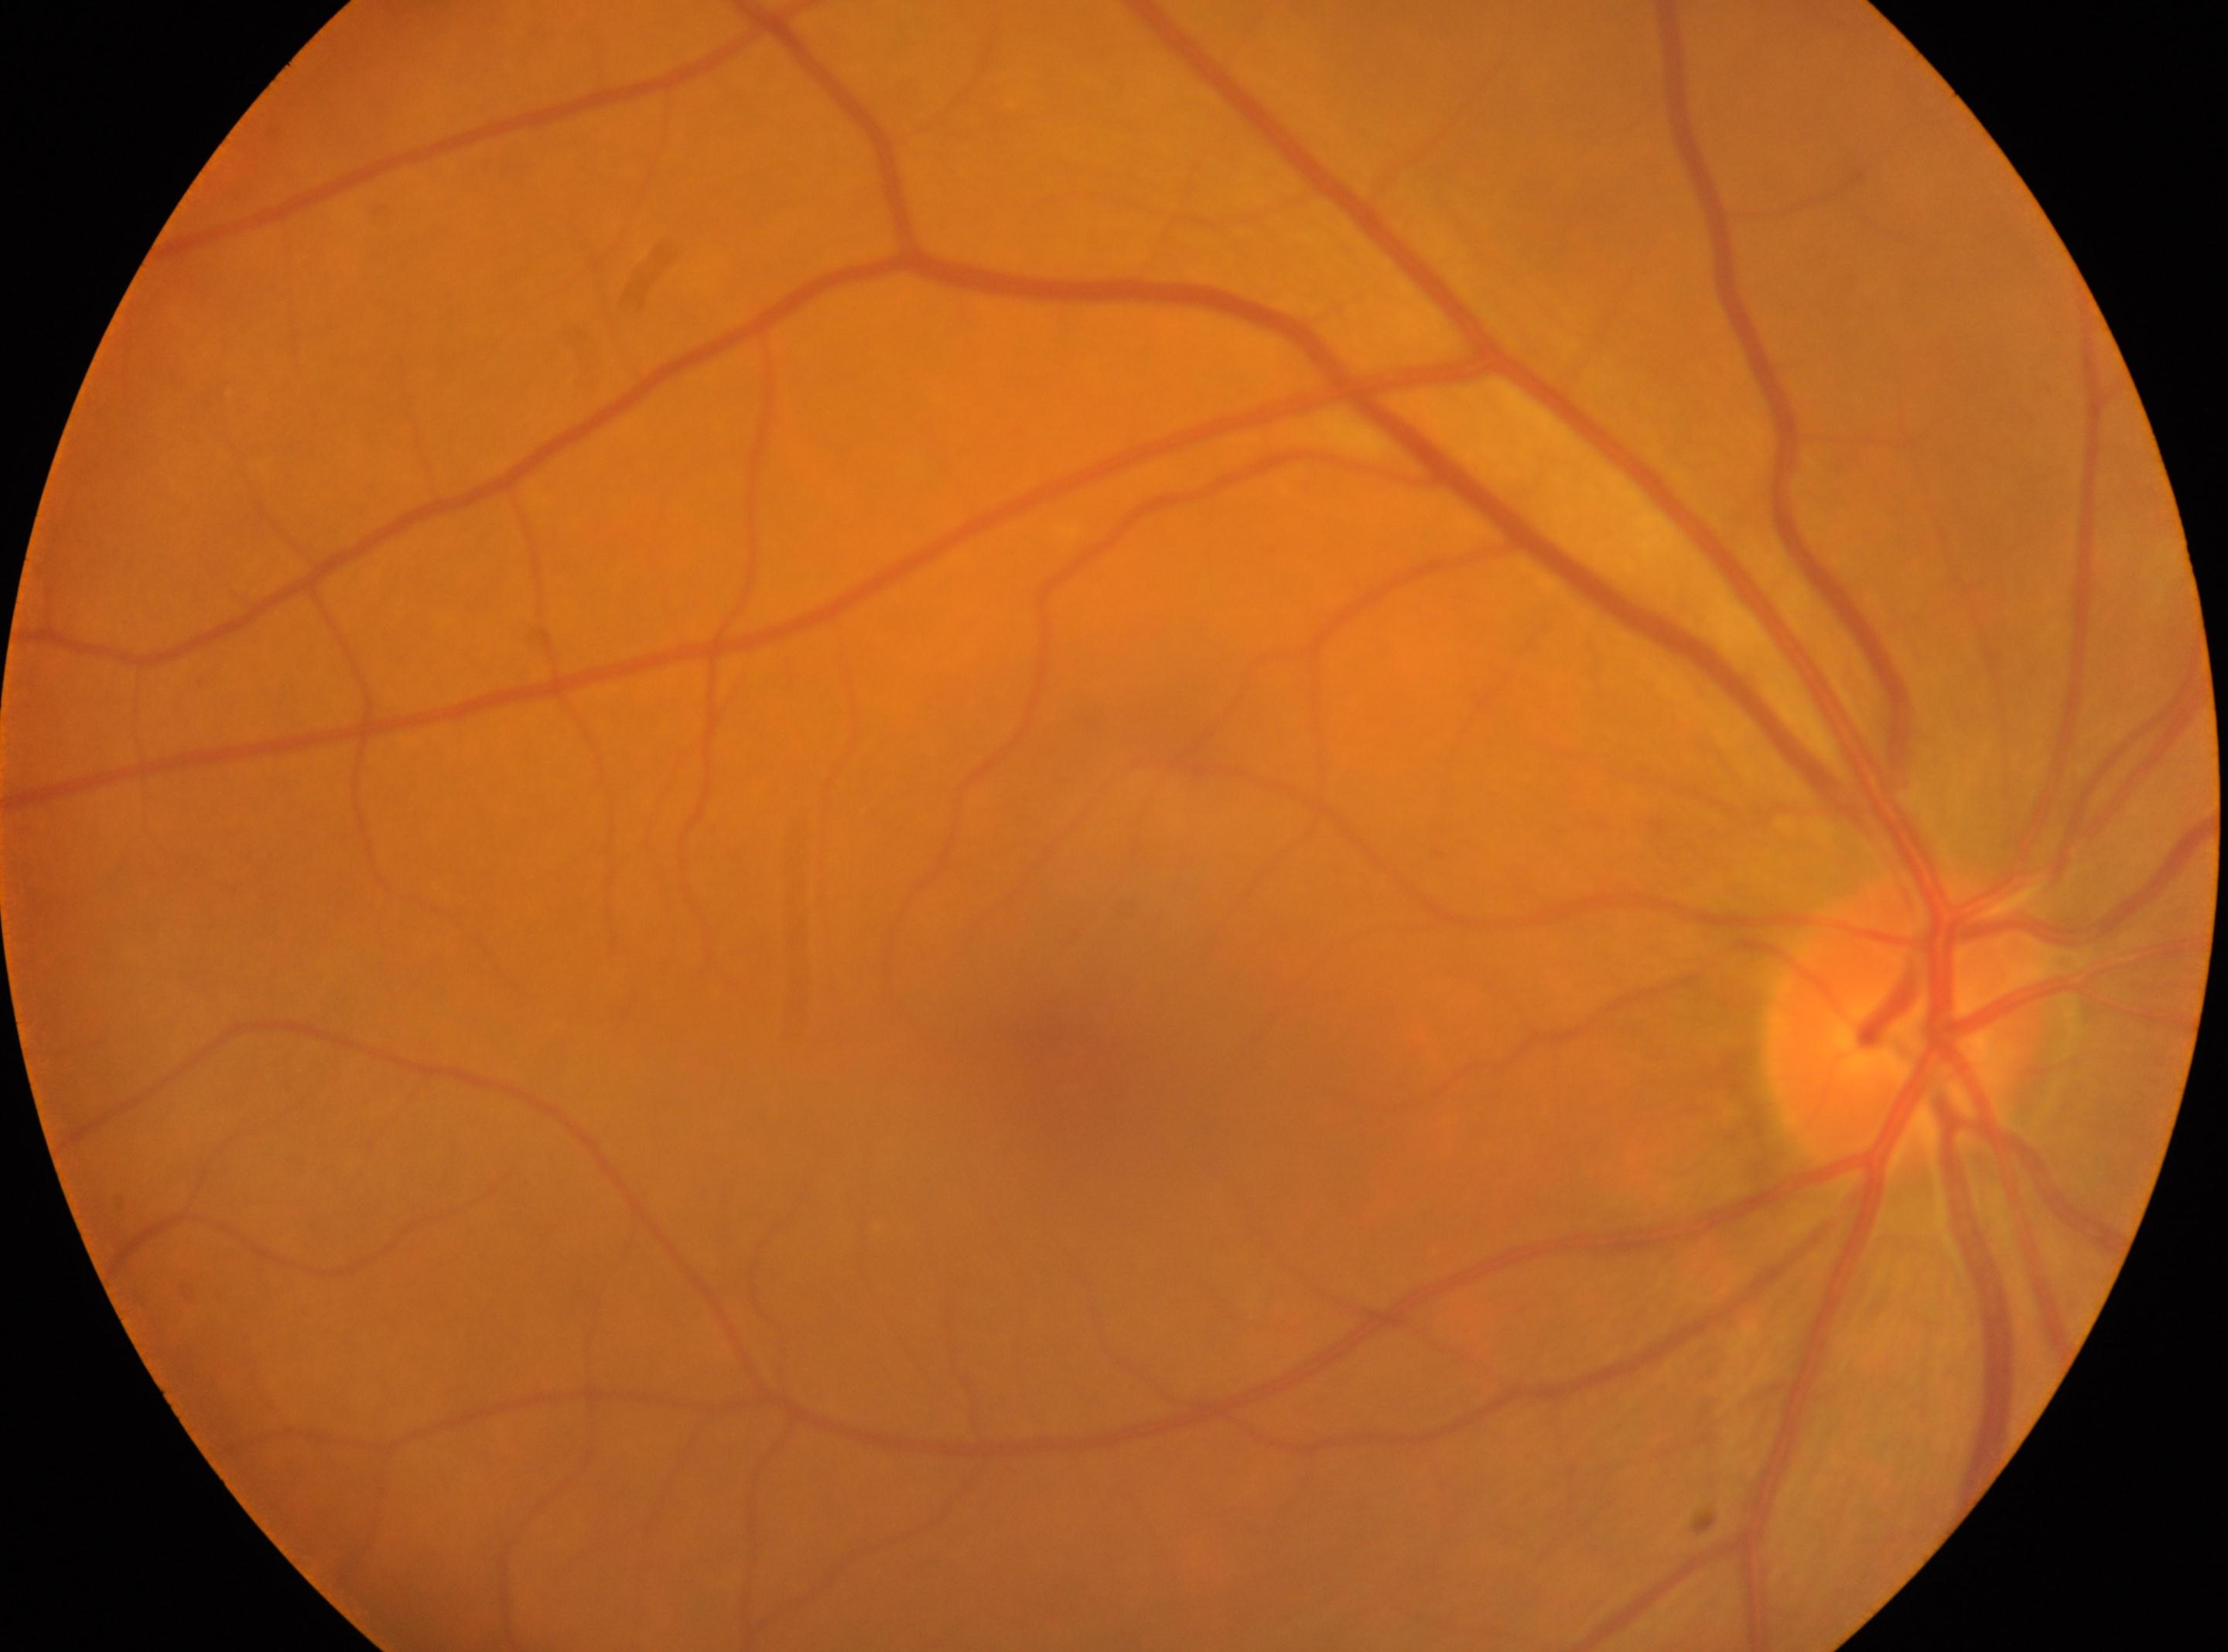

Eye: the right eye.
Foveal center located at (x=1080, y=1069).
ONH located at (x=1912, y=1023).
DR stage is no apparent retinopathy (grade 0).